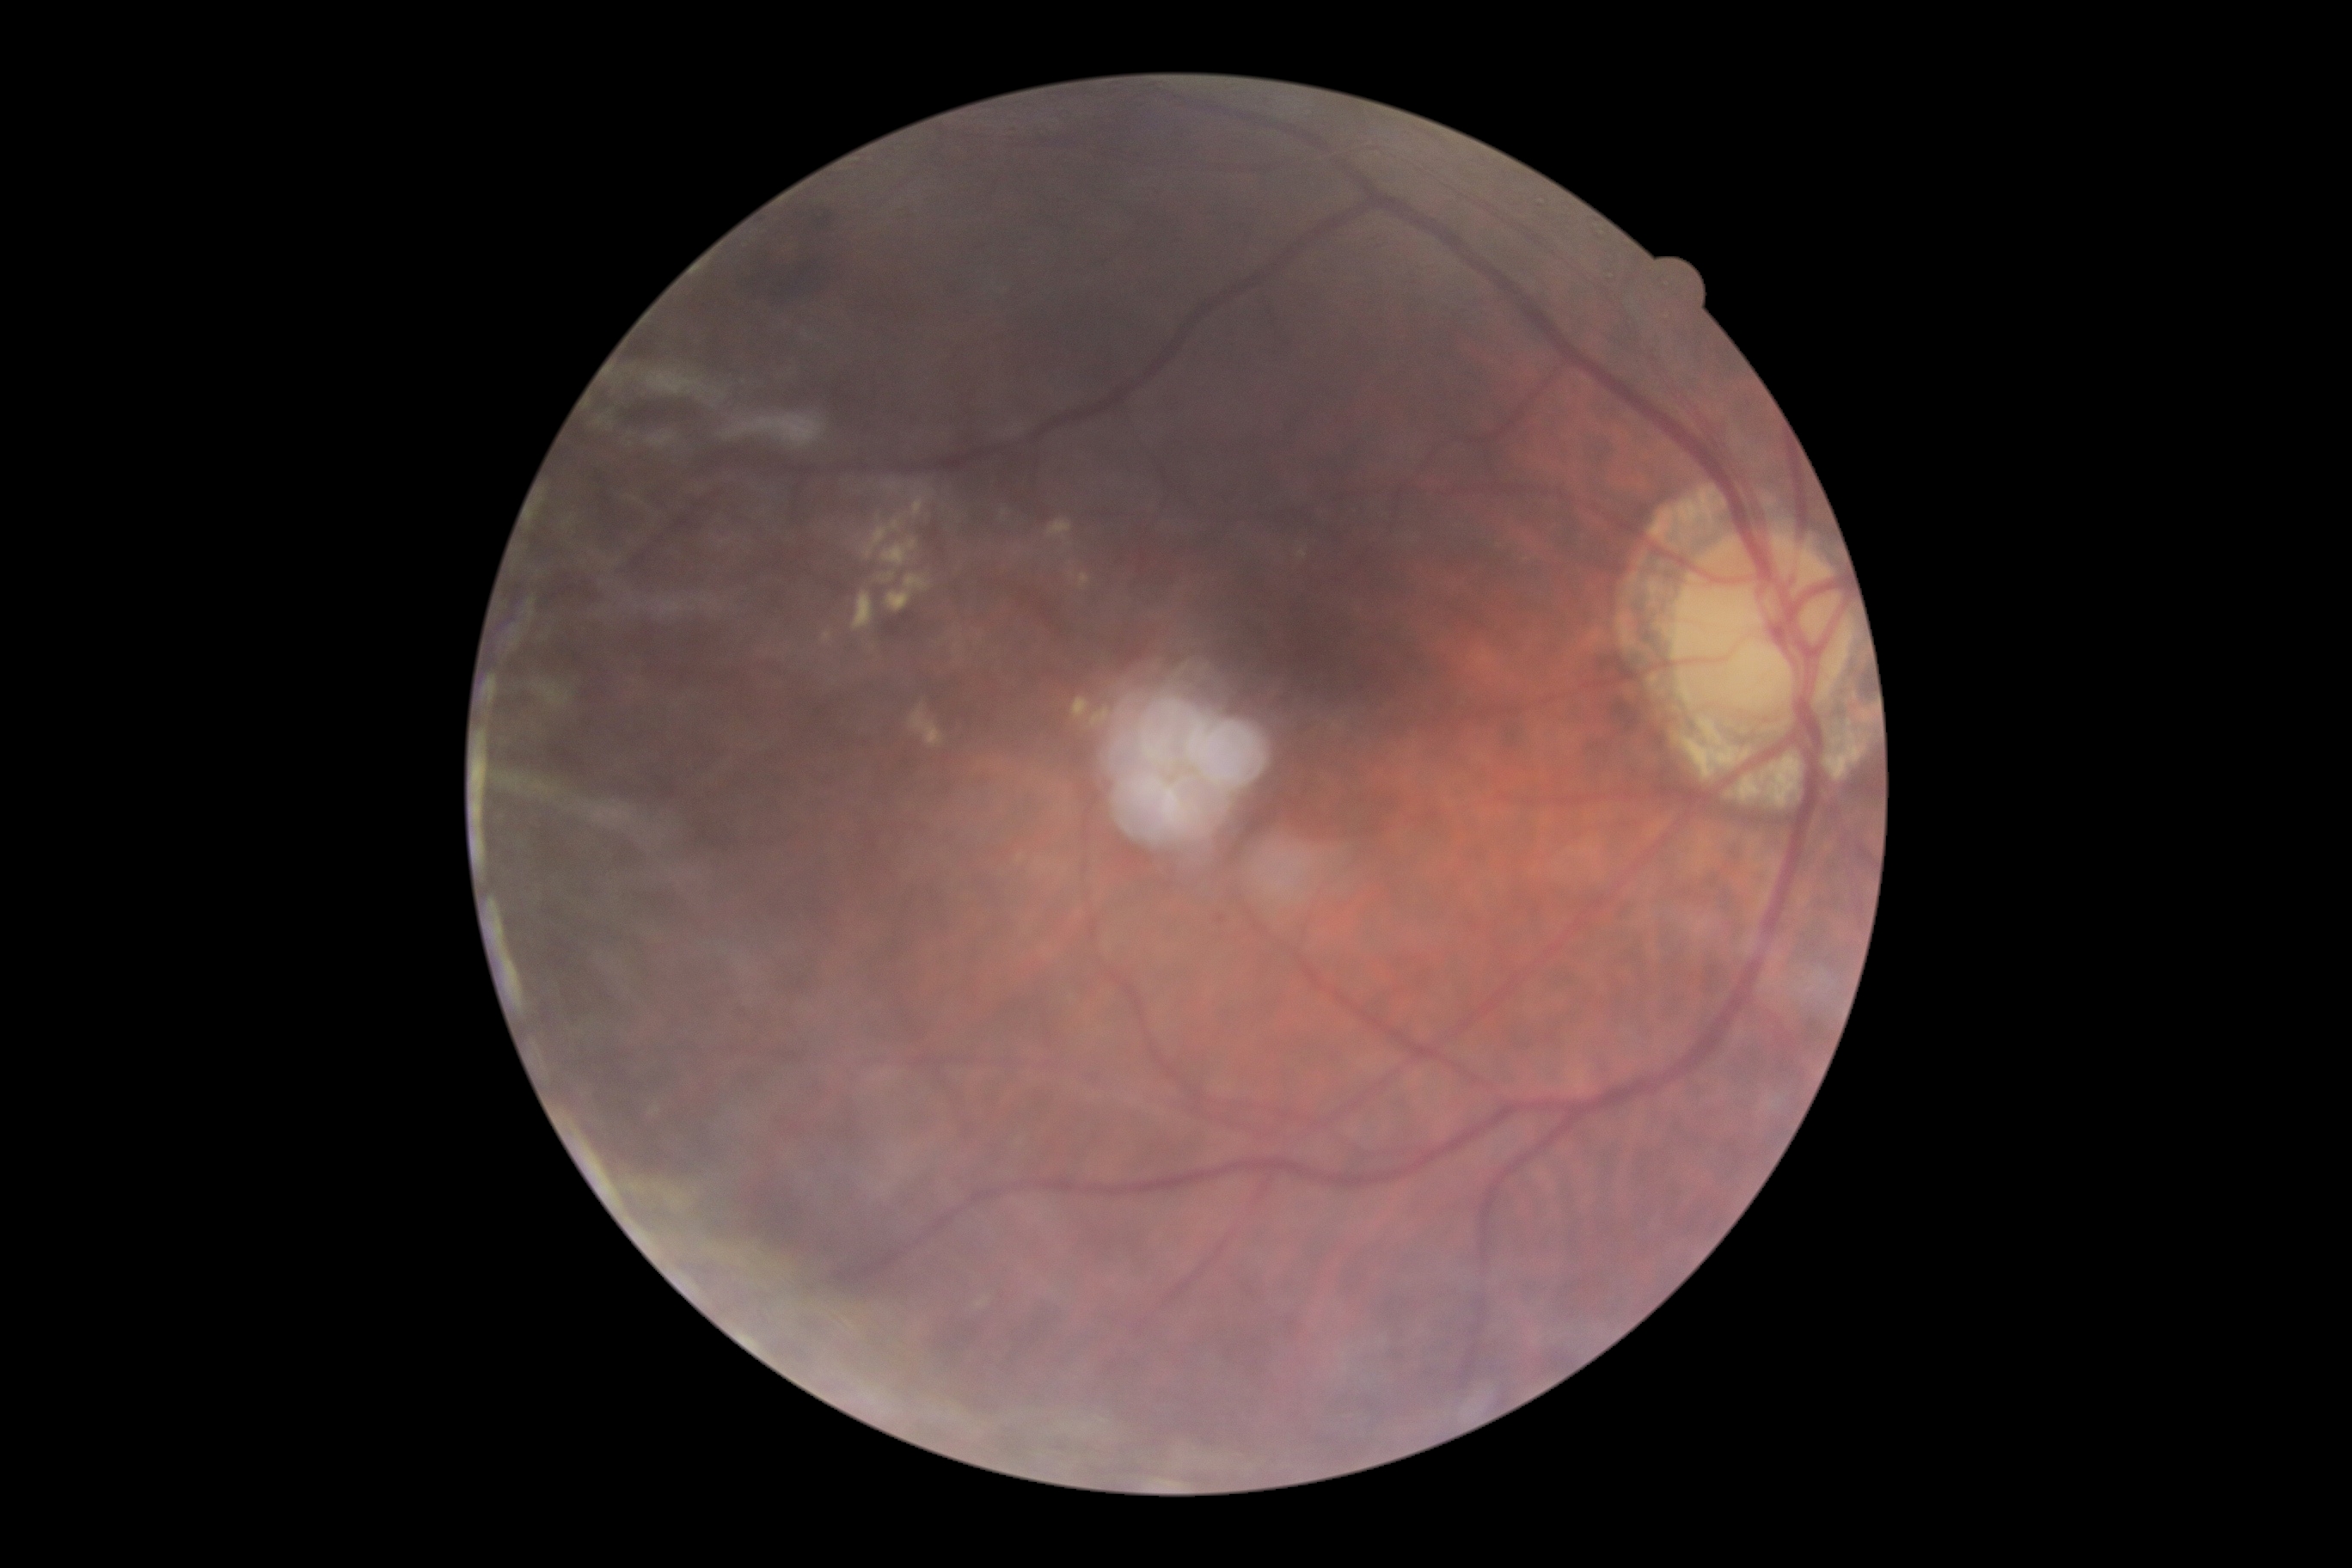

DR grade is moderate NPDR (2). Disease class: non-proliferative diabetic retinopathy.